Retinal fundus photograph — 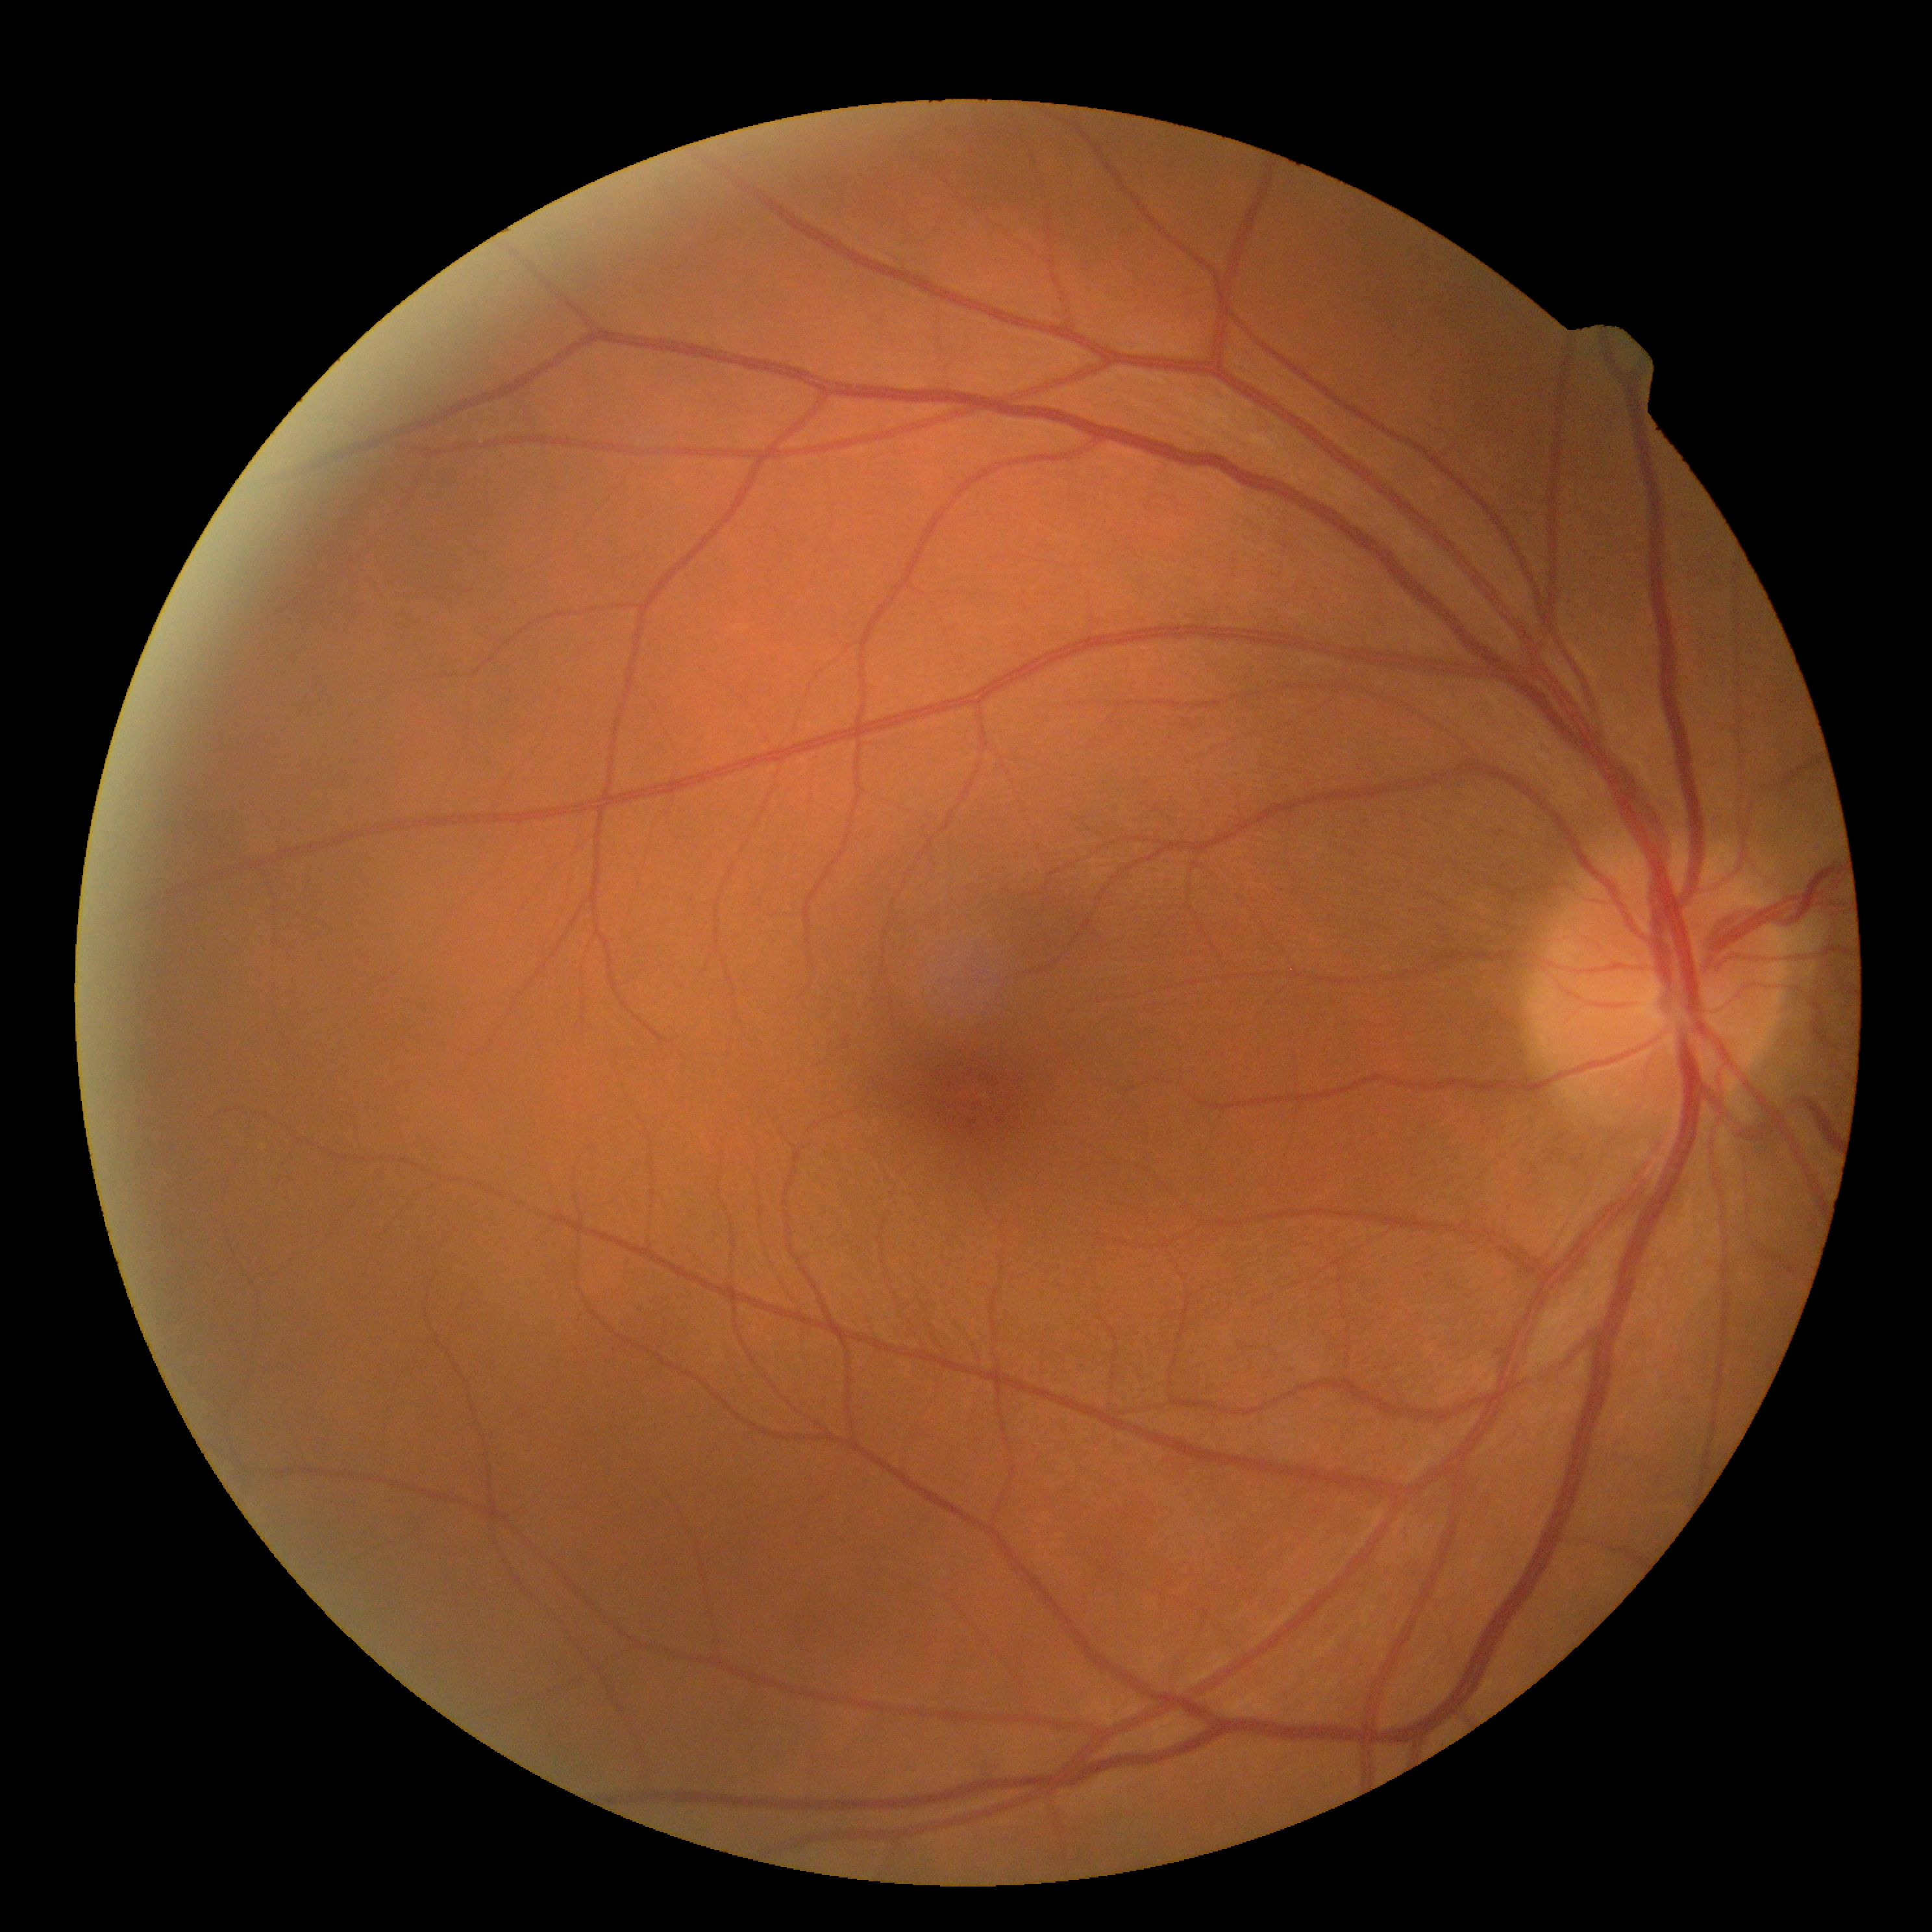

Diabetic retinopathy (DR) is grade 0 (no apparent retinopathy).